Color fundus image — 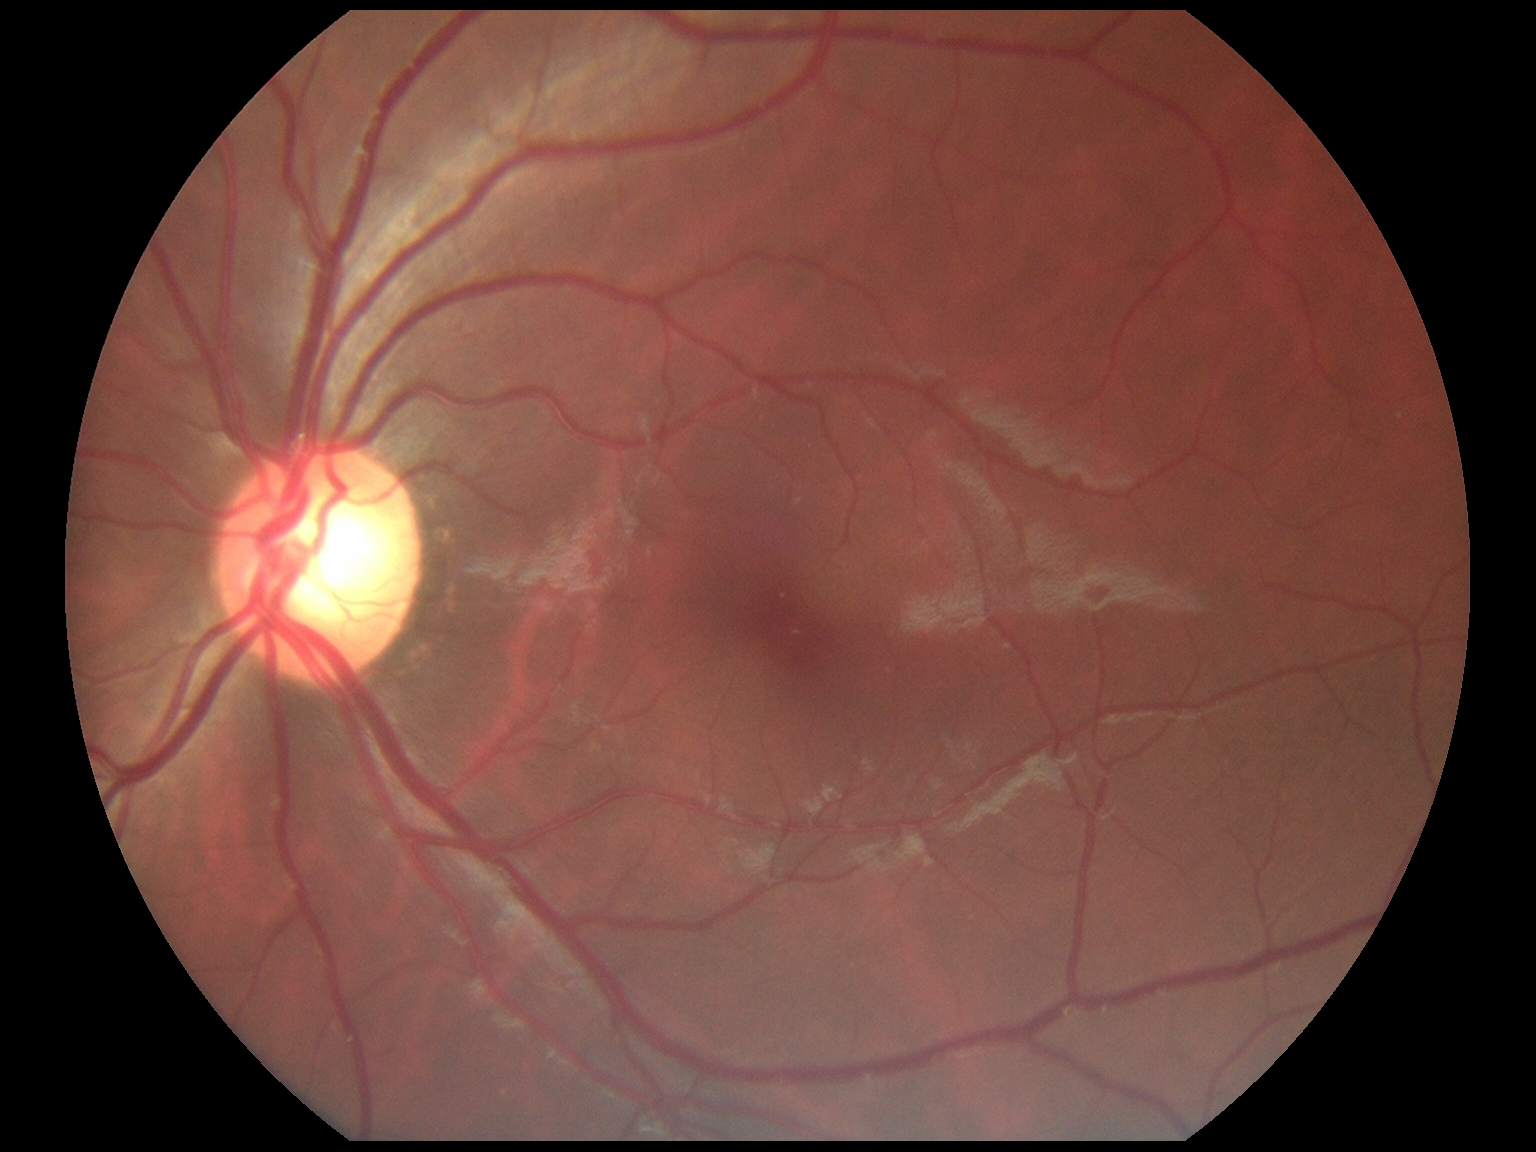
  dr_grade: 0/4
  dr_impression: no DR findings